Infant wide-field retinal image:
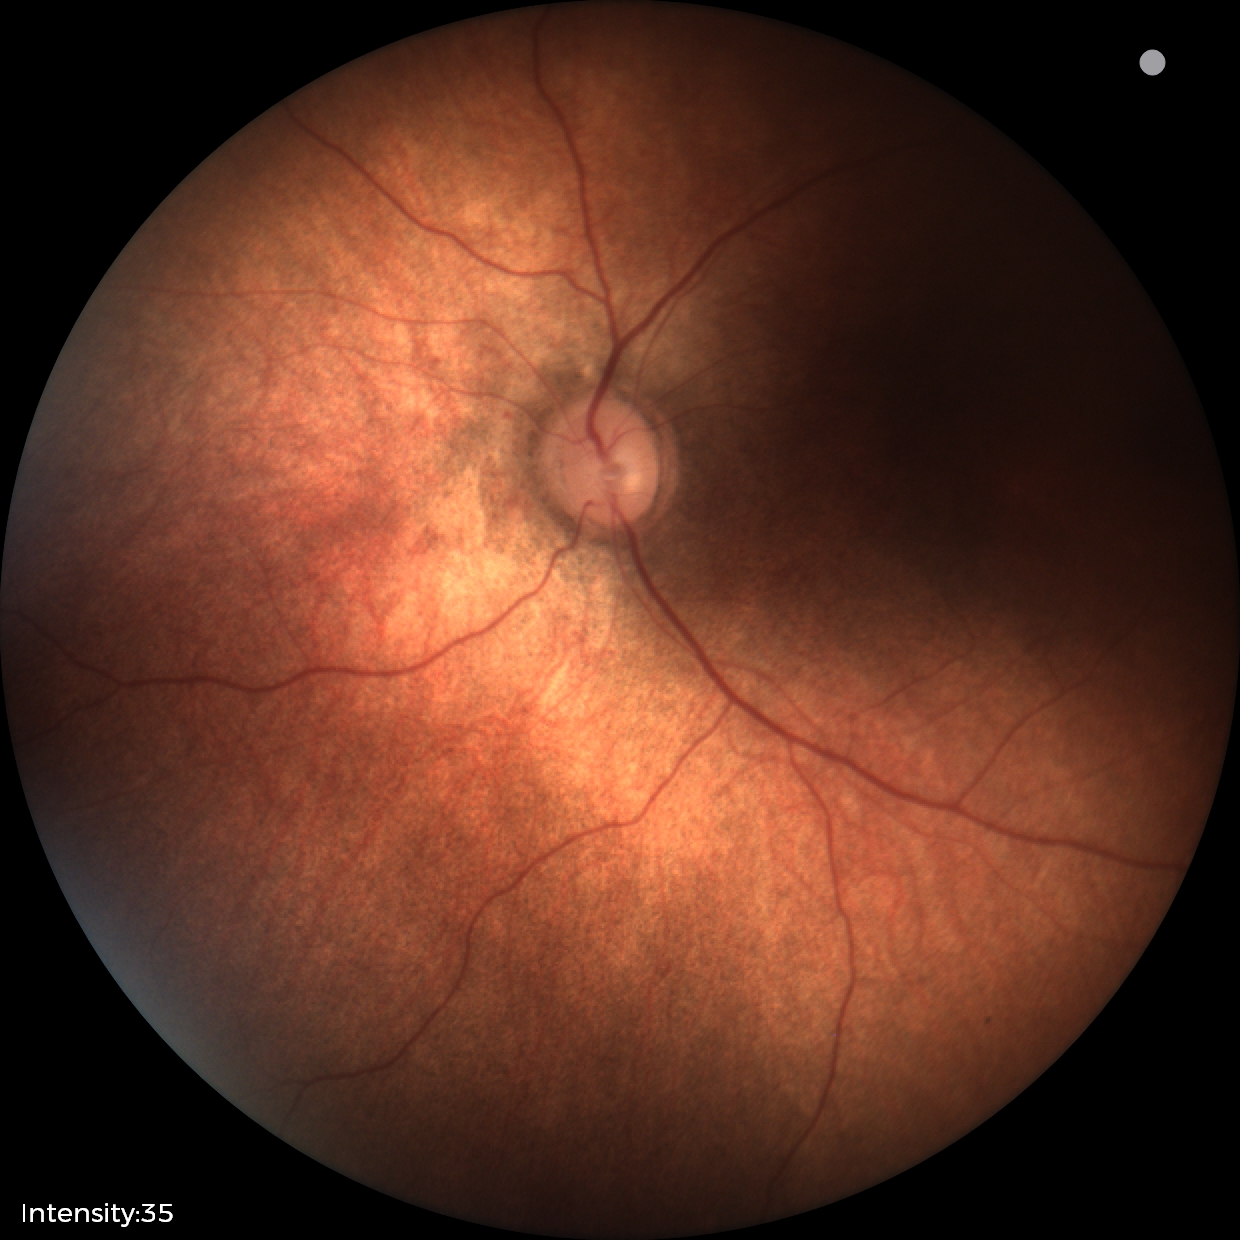

Physiological retinal appearance for postconceptual age.